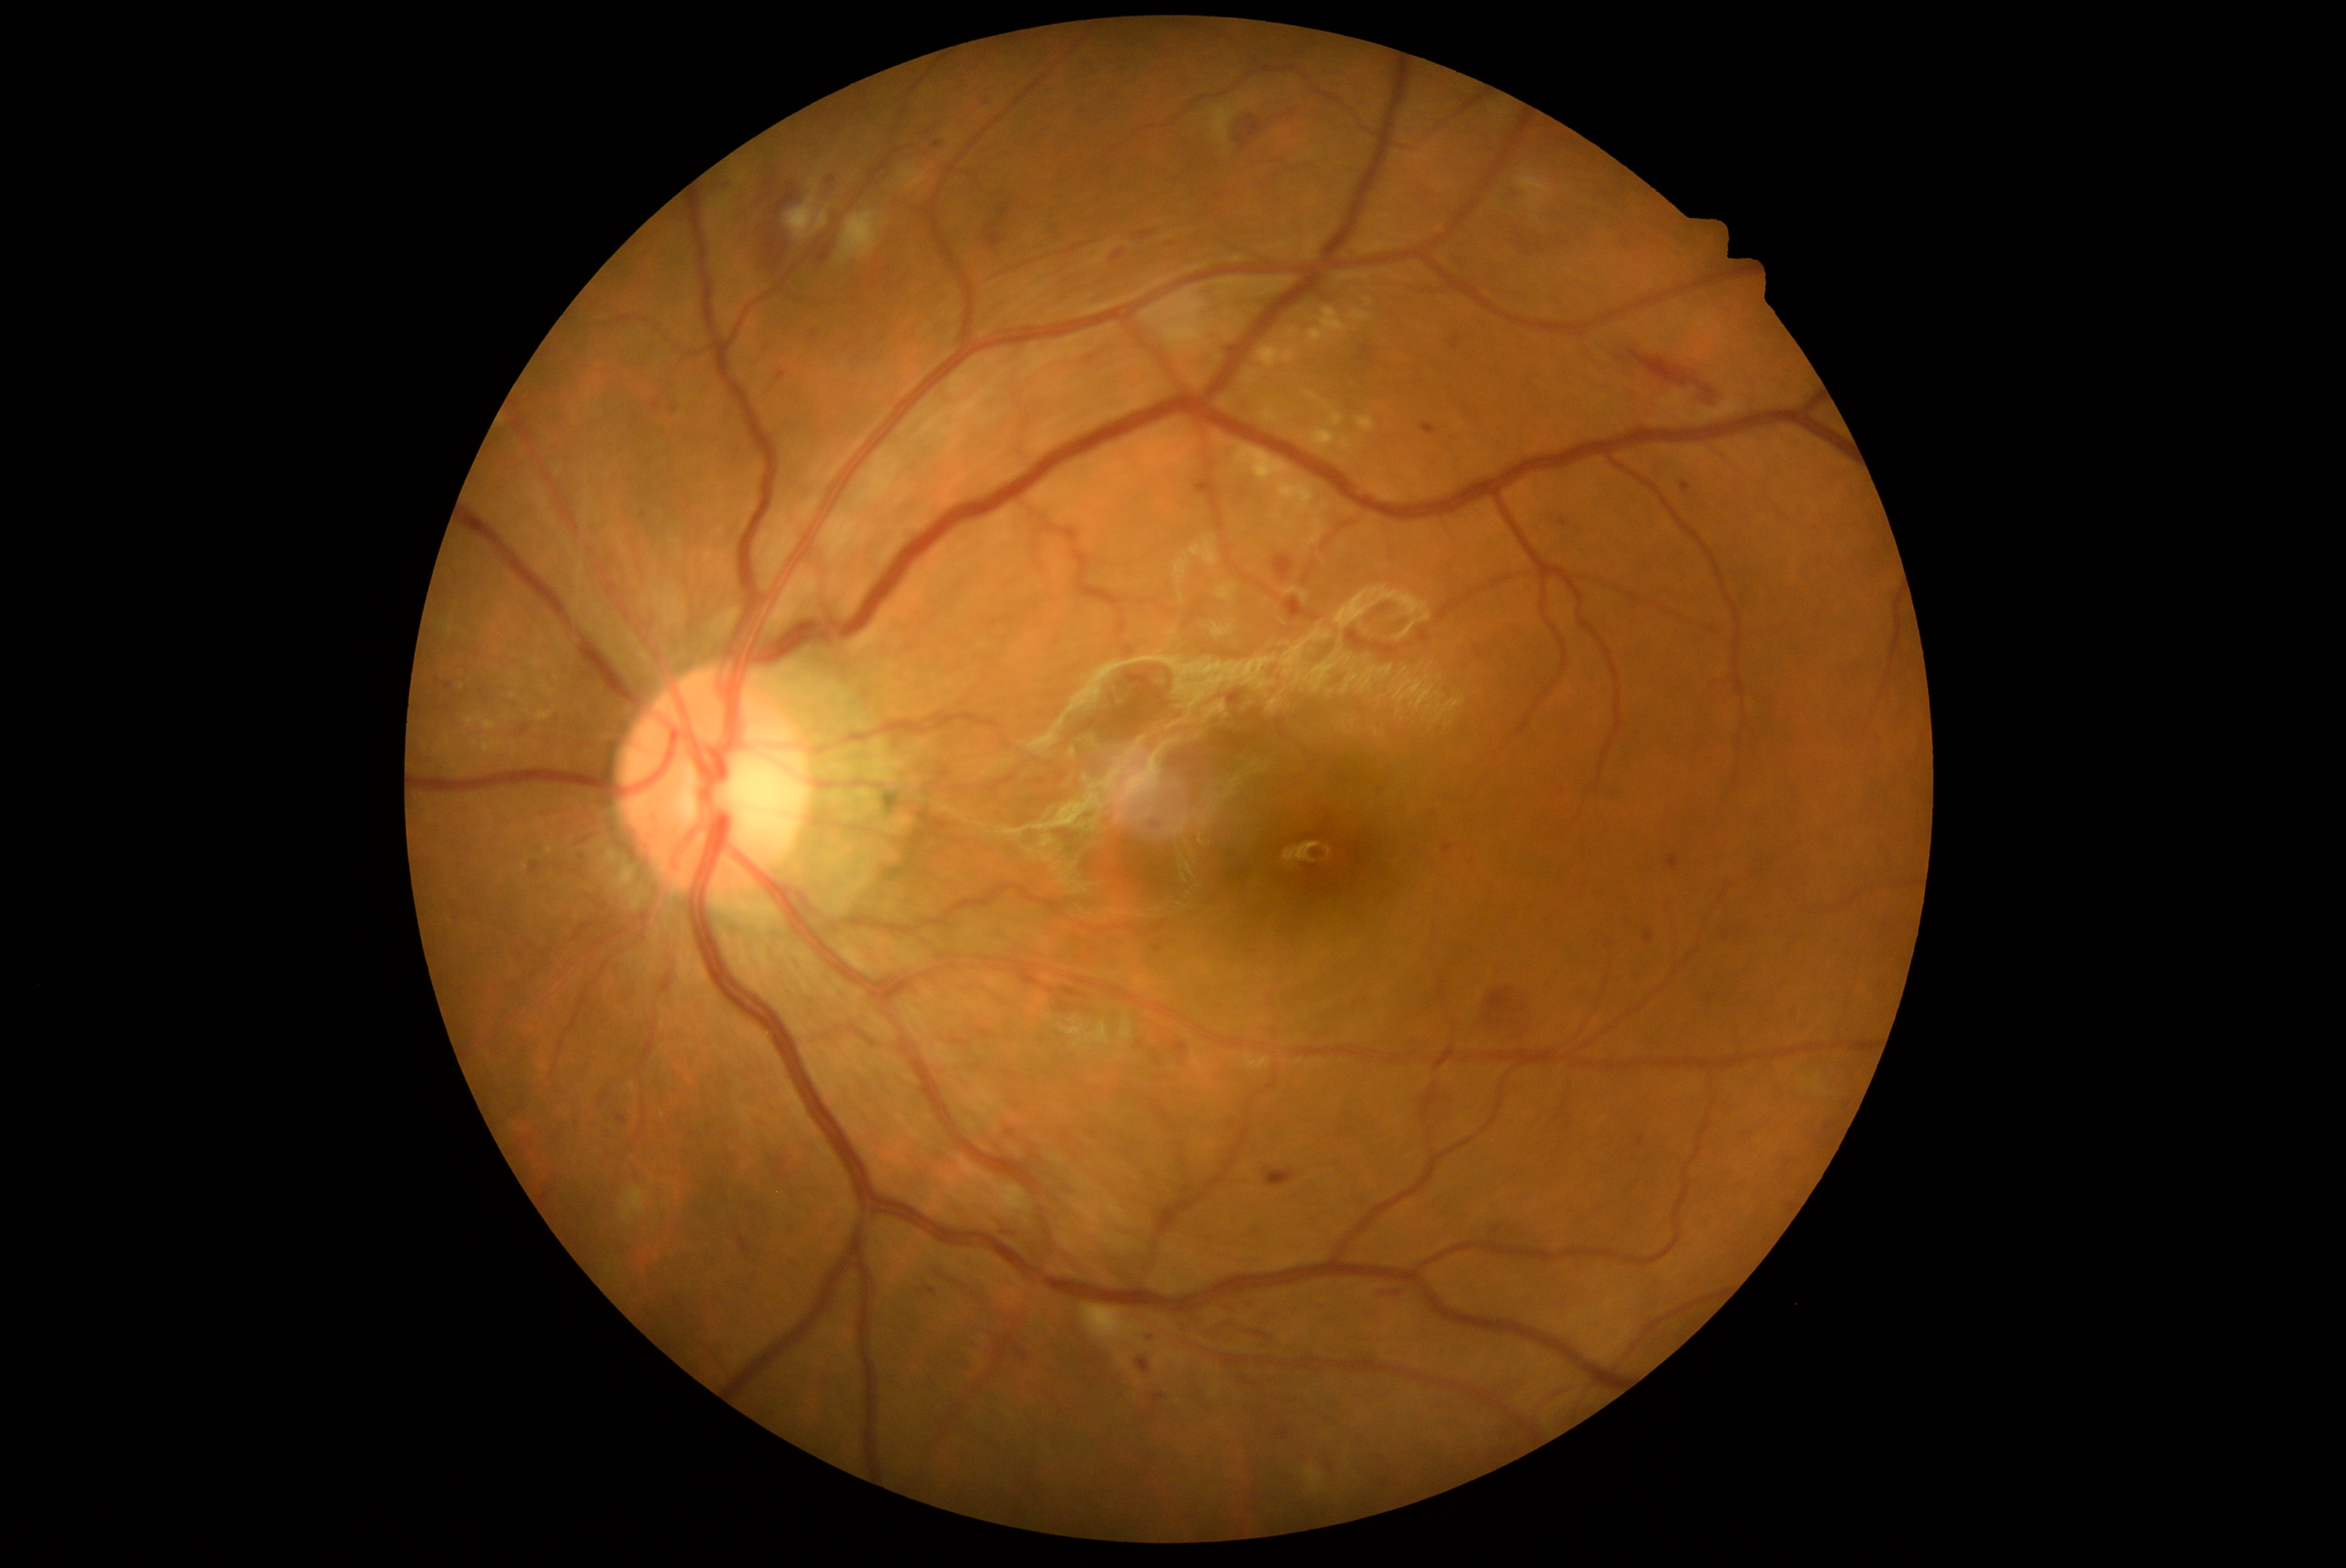 Diabetic retinopathy grade is 2
Representative lesions:
• soft exudates: {"x1": 1516, "y1": 170, "x2": 1555, "y2": 212}; {"x1": 838, "y1": 211, "x2": 885, "y2": 260}; {"x1": 465, "y1": 713, "x2": 498, "y2": 731}; {"x1": 448, "y1": 625, "x2": 457, "y2": 636}; {"x1": 622, "y1": 1186, "x2": 647, "y2": 1224}; {"x1": 536, "y1": 706, "x2": 556, "y2": 724}; {"x1": 1081, "y1": 1305, "x2": 1146, "y2": 1346}; {"x1": 786, "y1": 195, "x2": 818, "y2": 241}; {"x1": 1210, "y1": 95, "x2": 1255, "y2": 140}
• Small soft exudates near x=461, y=686
• hard exudates: {"x1": 1258, "y1": 347, "x2": 1298, "y2": 368}; {"x1": 1331, "y1": 412, "x2": 1345, "y2": 427}; {"x1": 1233, "y1": 445, "x2": 1324, "y2": 546}; {"x1": 1349, "y1": 310, "x2": 1373, "y2": 322}; {"x1": 1356, "y1": 416, "x2": 1376, "y2": 432}; {"x1": 1307, "y1": 308, "x2": 1349, "y2": 344}; {"x1": 1313, "y1": 429, "x2": 1337, "y2": 448}
• microaneurysms (partial): {"x1": 446, "y1": 683, "x2": 452, "y2": 691}; {"x1": 992, "y1": 619, "x2": 997, "y2": 628}; {"x1": 1113, "y1": 250, "x2": 1124, "y2": 261}; {"x1": 1152, "y1": 1395, "x2": 1166, "y2": 1407}; {"x1": 1279, "y1": 1431, "x2": 1288, "y2": 1437}; {"x1": 979, "y1": 1029, "x2": 995, "y2": 1039}; {"x1": 1349, "y1": 846, "x2": 1364, "y2": 865}; {"x1": 1155, "y1": 946, "x2": 1163, "y2": 954}; {"x1": 435, "y1": 678, "x2": 440, "y2": 686}; {"x1": 1494, "y1": 1227, "x2": 1502, "y2": 1236}; {"x1": 1194, "y1": 481, "x2": 1204, "y2": 495}; {"x1": 774, "y1": 1160, "x2": 785, "y2": 1169}; {"x1": 617, "y1": 1117, "x2": 628, "y2": 1125}; {"x1": 827, "y1": 176, "x2": 835, "y2": 184}; {"x1": 529, "y1": 862, "x2": 542, "y2": 874}
• Small microaneurysms near x=1011, y=1133; x=937, y=145; x=1384, y=1486
• hemorrhages (partial): {"x1": 998, "y1": 205, "x2": 1011, "y2": 219}; {"x1": 1487, "y1": 987, "x2": 1513, "y2": 1012}; {"x1": 1420, "y1": 1084, "x2": 1442, "y2": 1122}; {"x1": 1274, "y1": 554, "x2": 1295, "y2": 581}; {"x1": 1627, "y1": 350, "x2": 1688, "y2": 387}; {"x1": 1381, "y1": 1291, "x2": 1403, "y2": 1298}; {"x1": 1237, "y1": 137, "x2": 1246, "y2": 150}; {"x1": 1247, "y1": 117, "x2": 1262, "y2": 137}; {"x1": 1690, "y1": 380, "x2": 1698, "y2": 385}; {"x1": 739, "y1": 1238, "x2": 750, "y2": 1254}; {"x1": 1266, "y1": 1167, "x2": 1296, "y2": 1188}; {"x1": 1061, "y1": 987, "x2": 1081, "y2": 998}